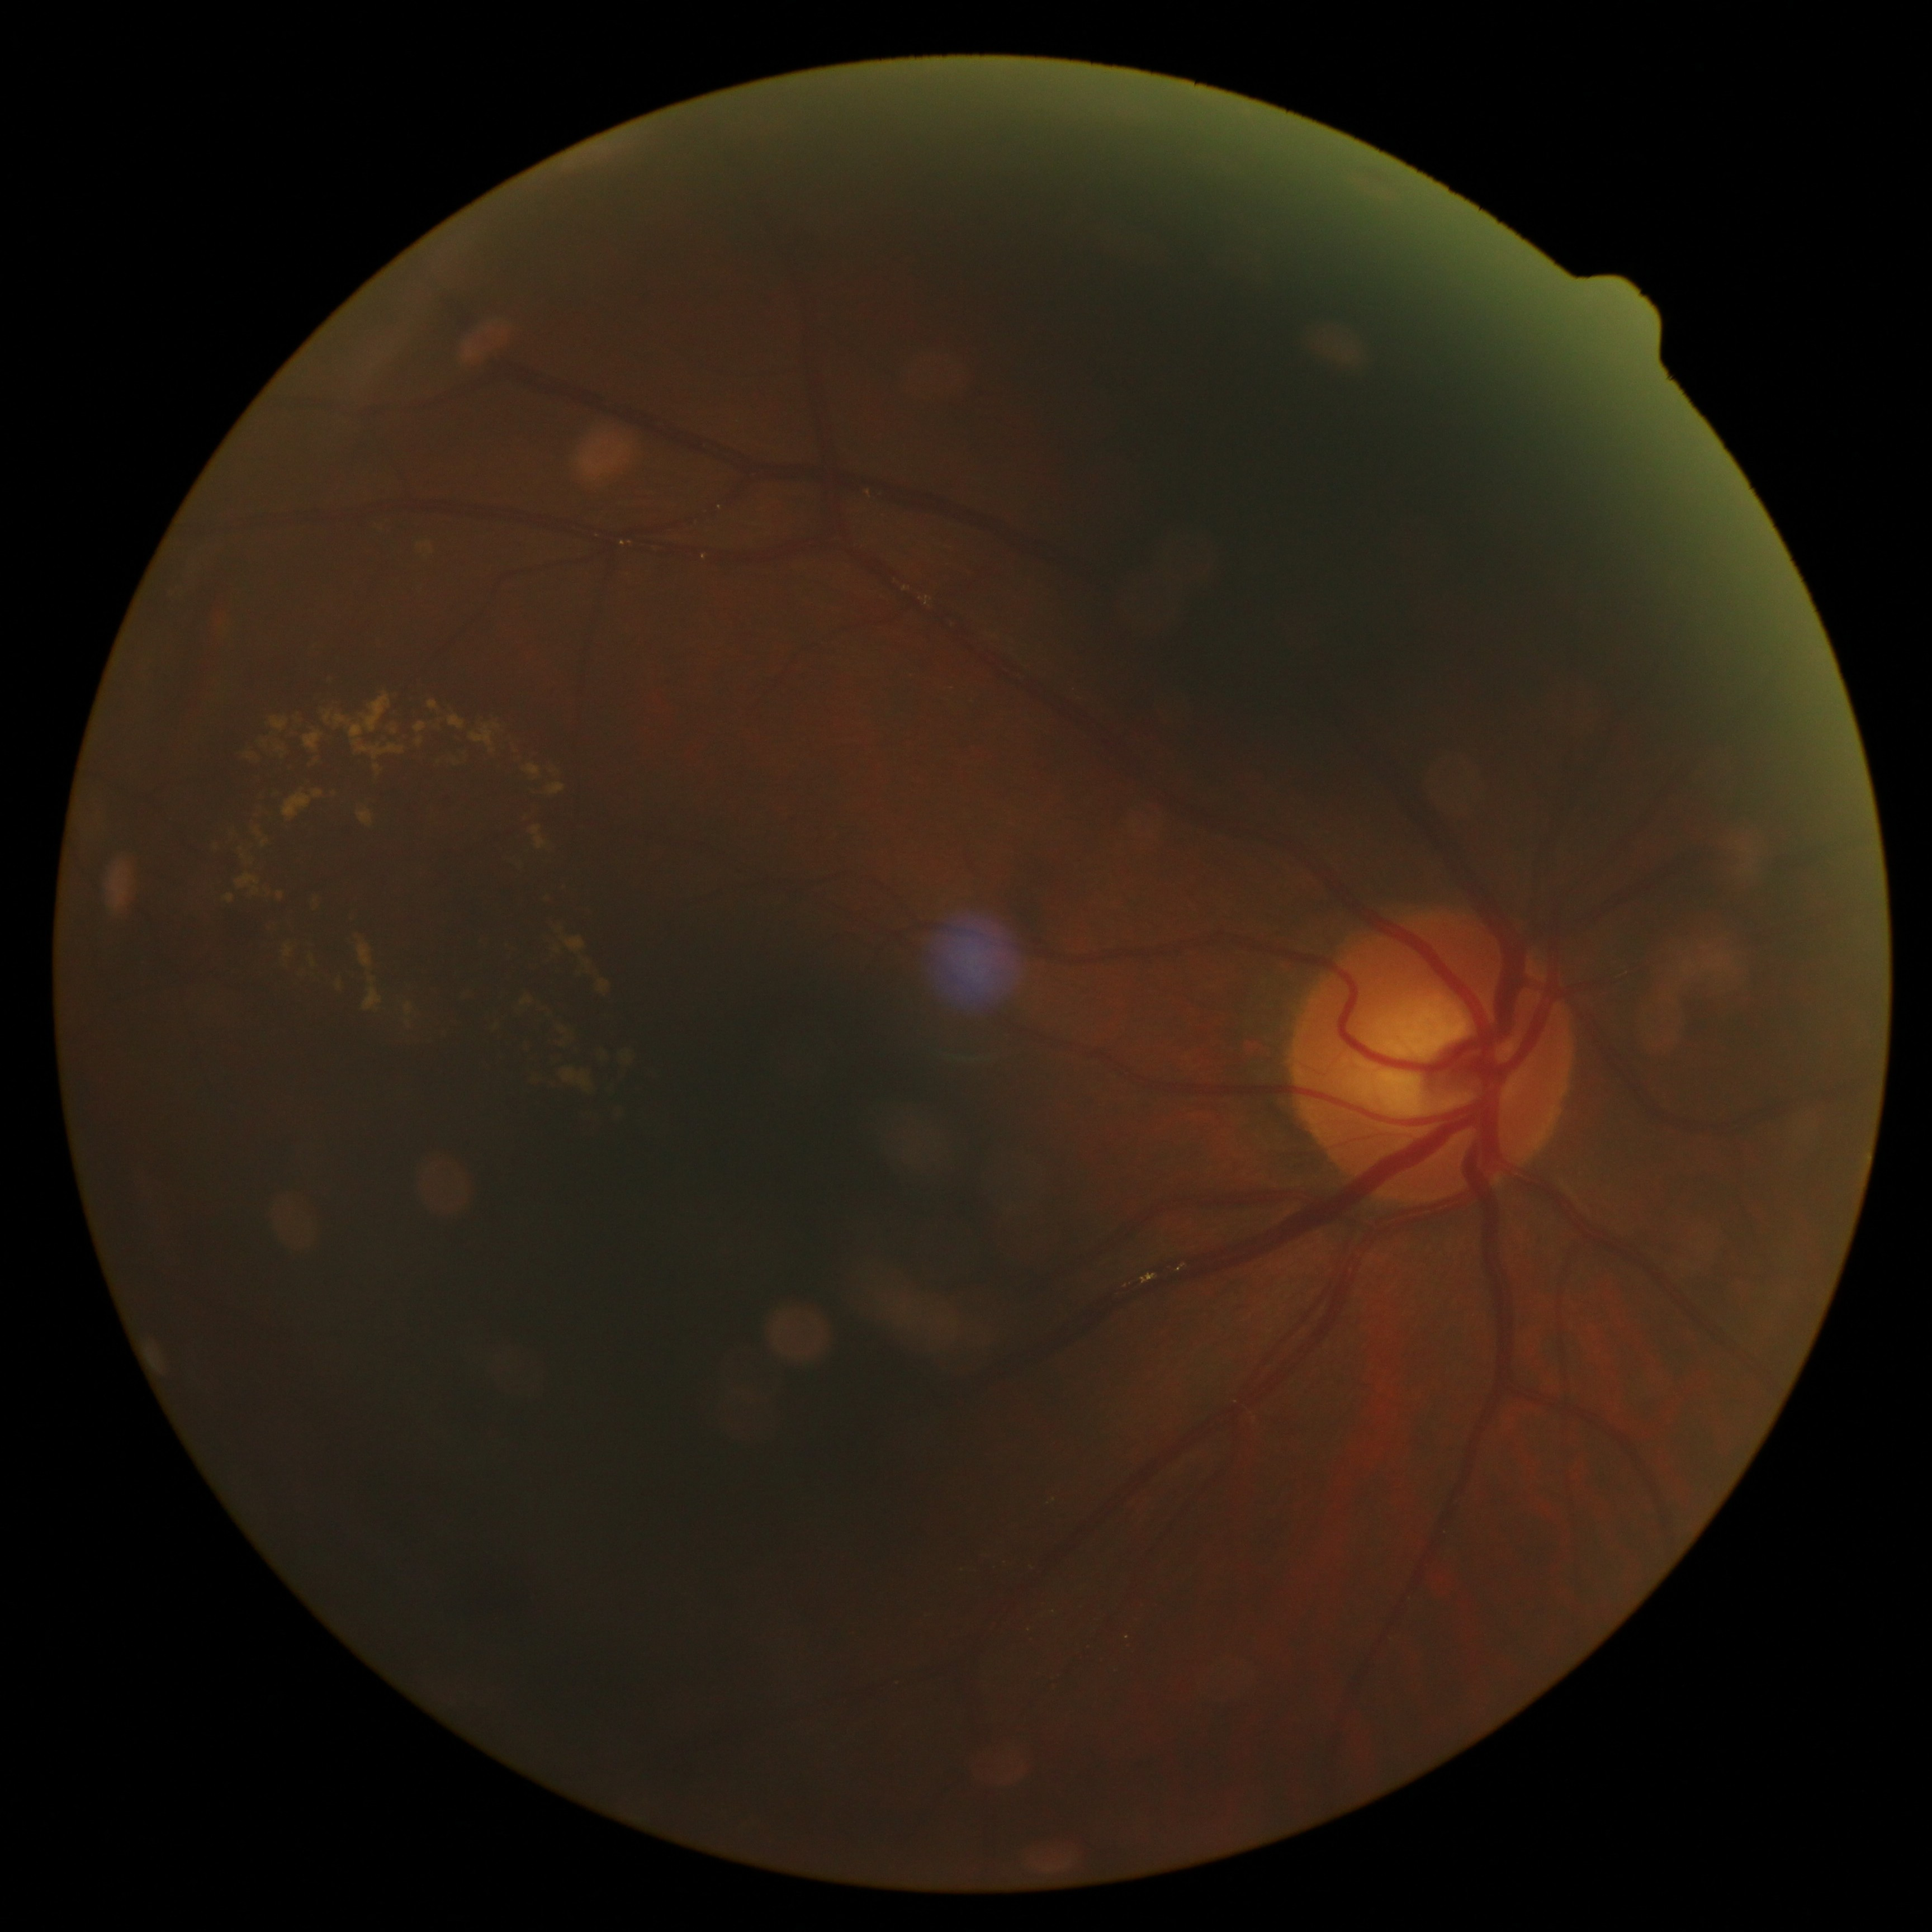
DR grade@moderate NPDR (2) — more than just microaneurysms but less than severe NPDR.